Retinal fundus photograph — 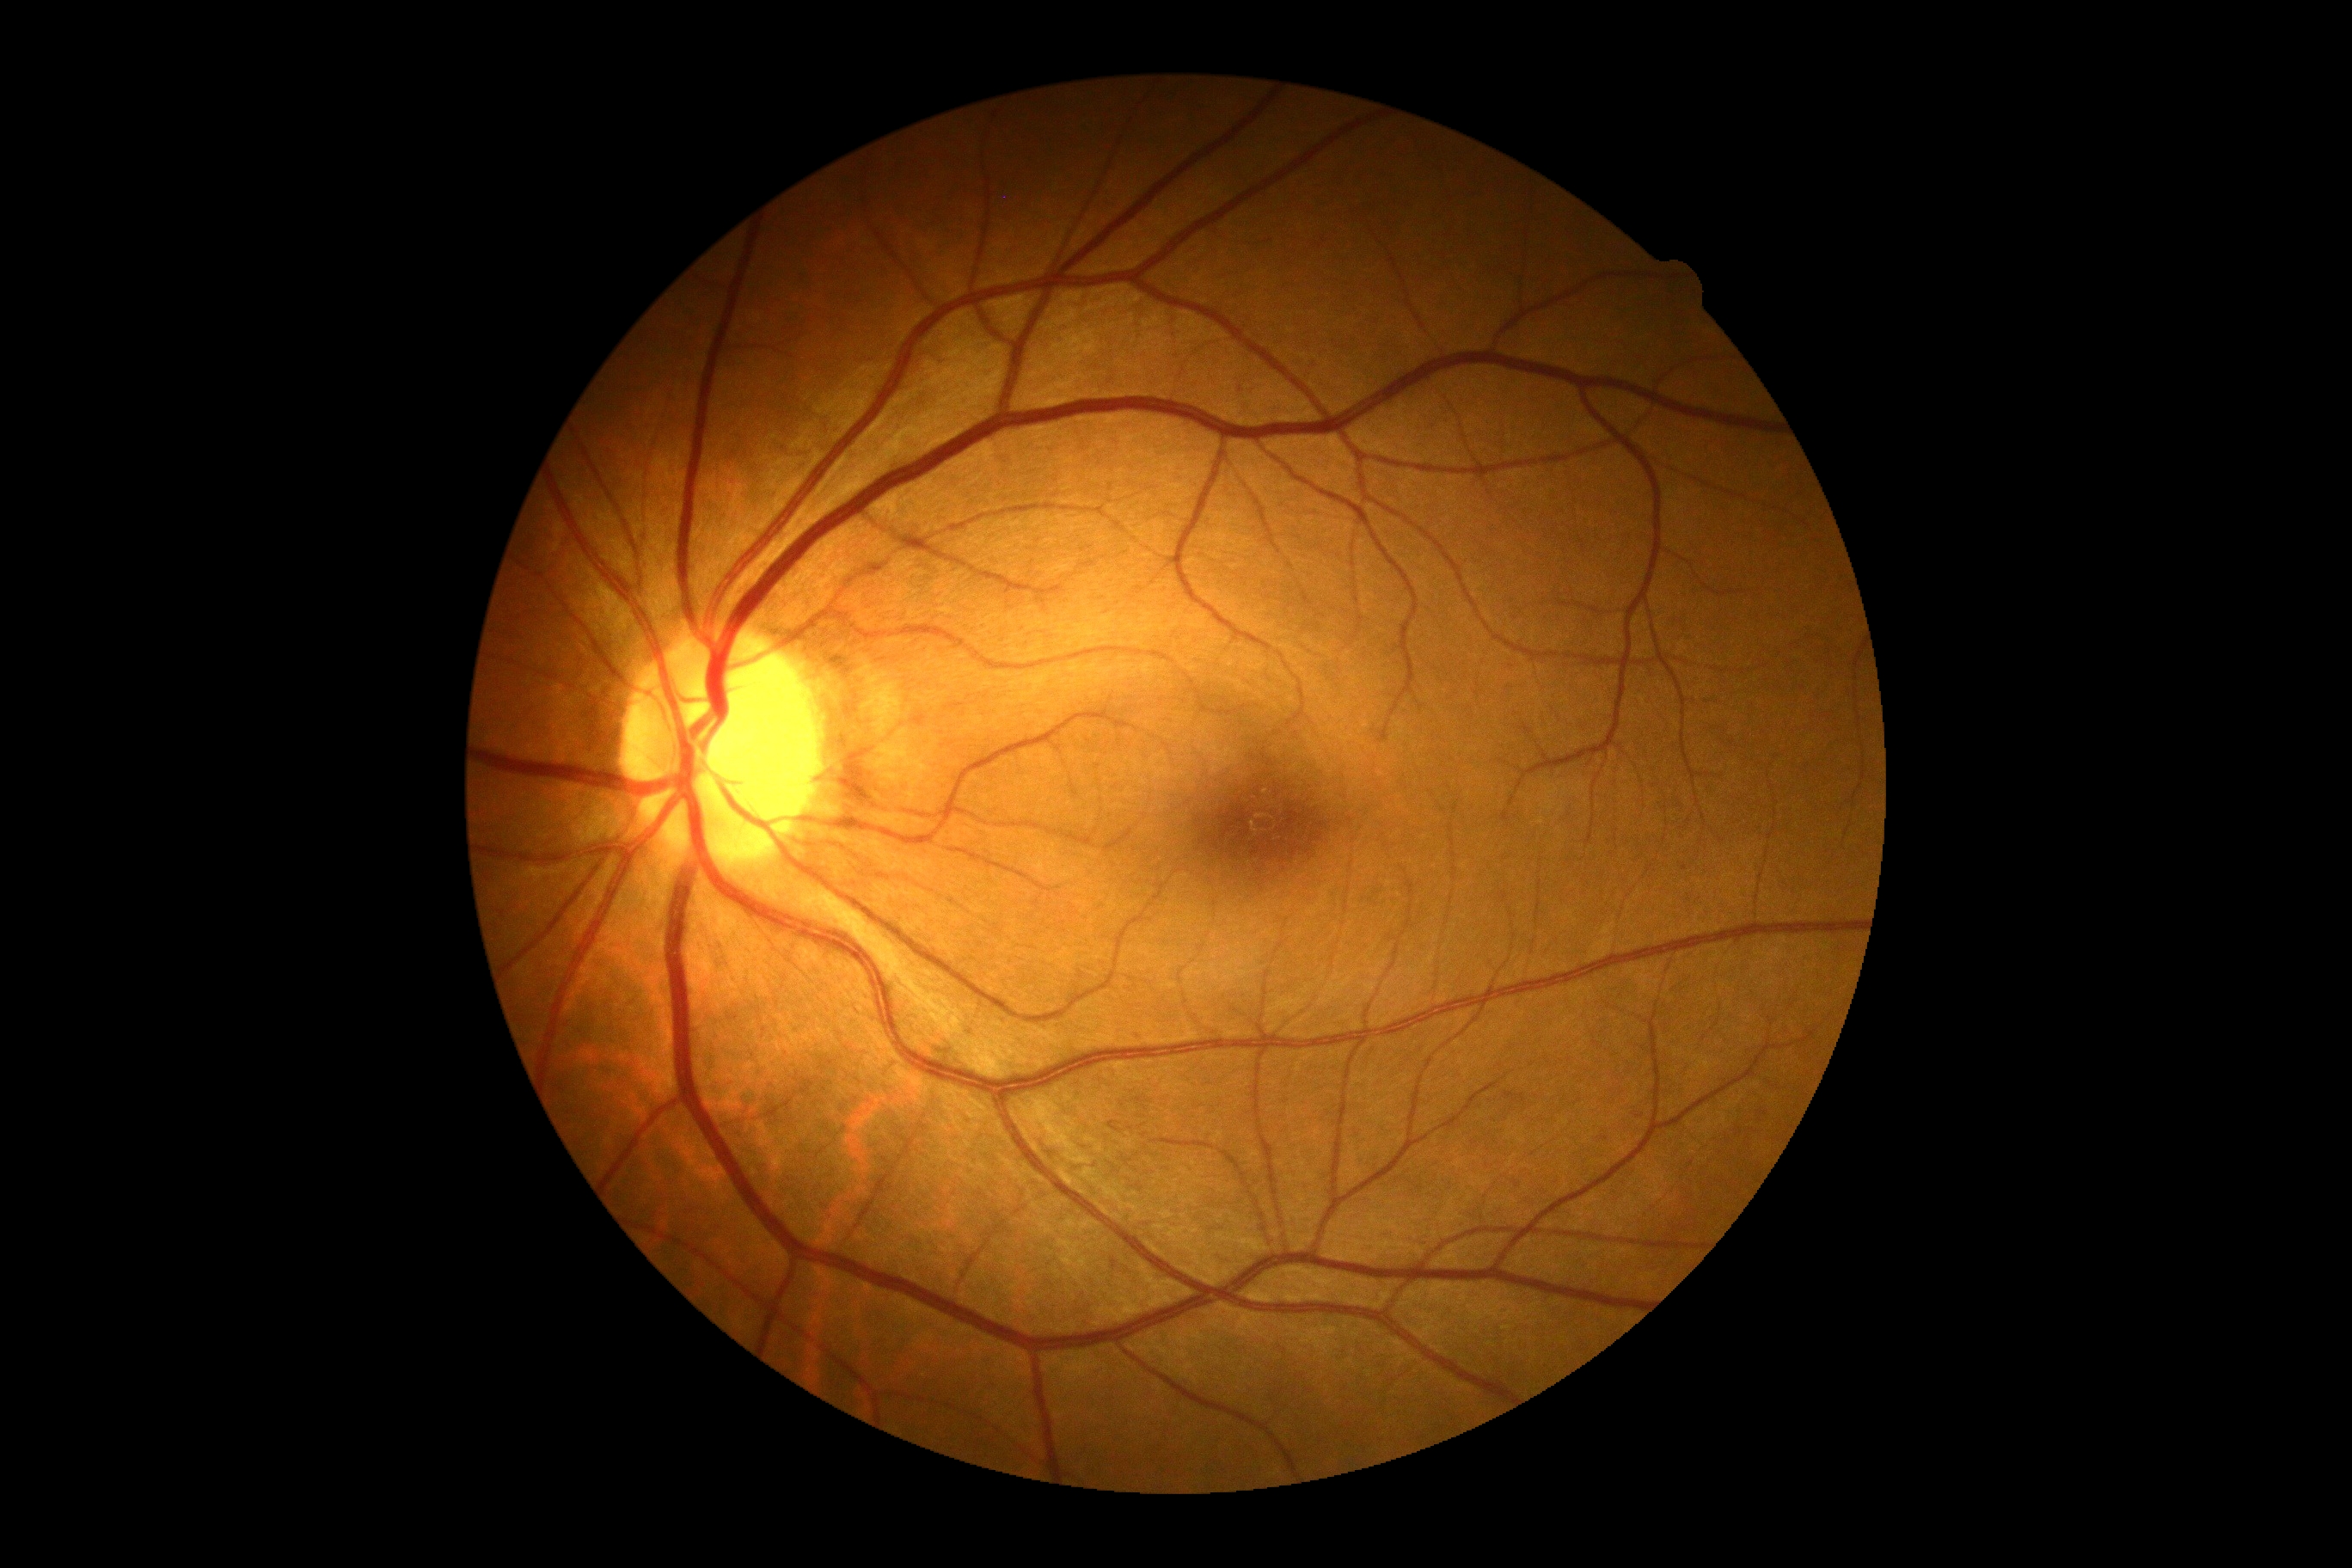
Diabetic retinopathy (DR) is grade 0 (no apparent retinopathy) — no visible signs of diabetic retinopathy.